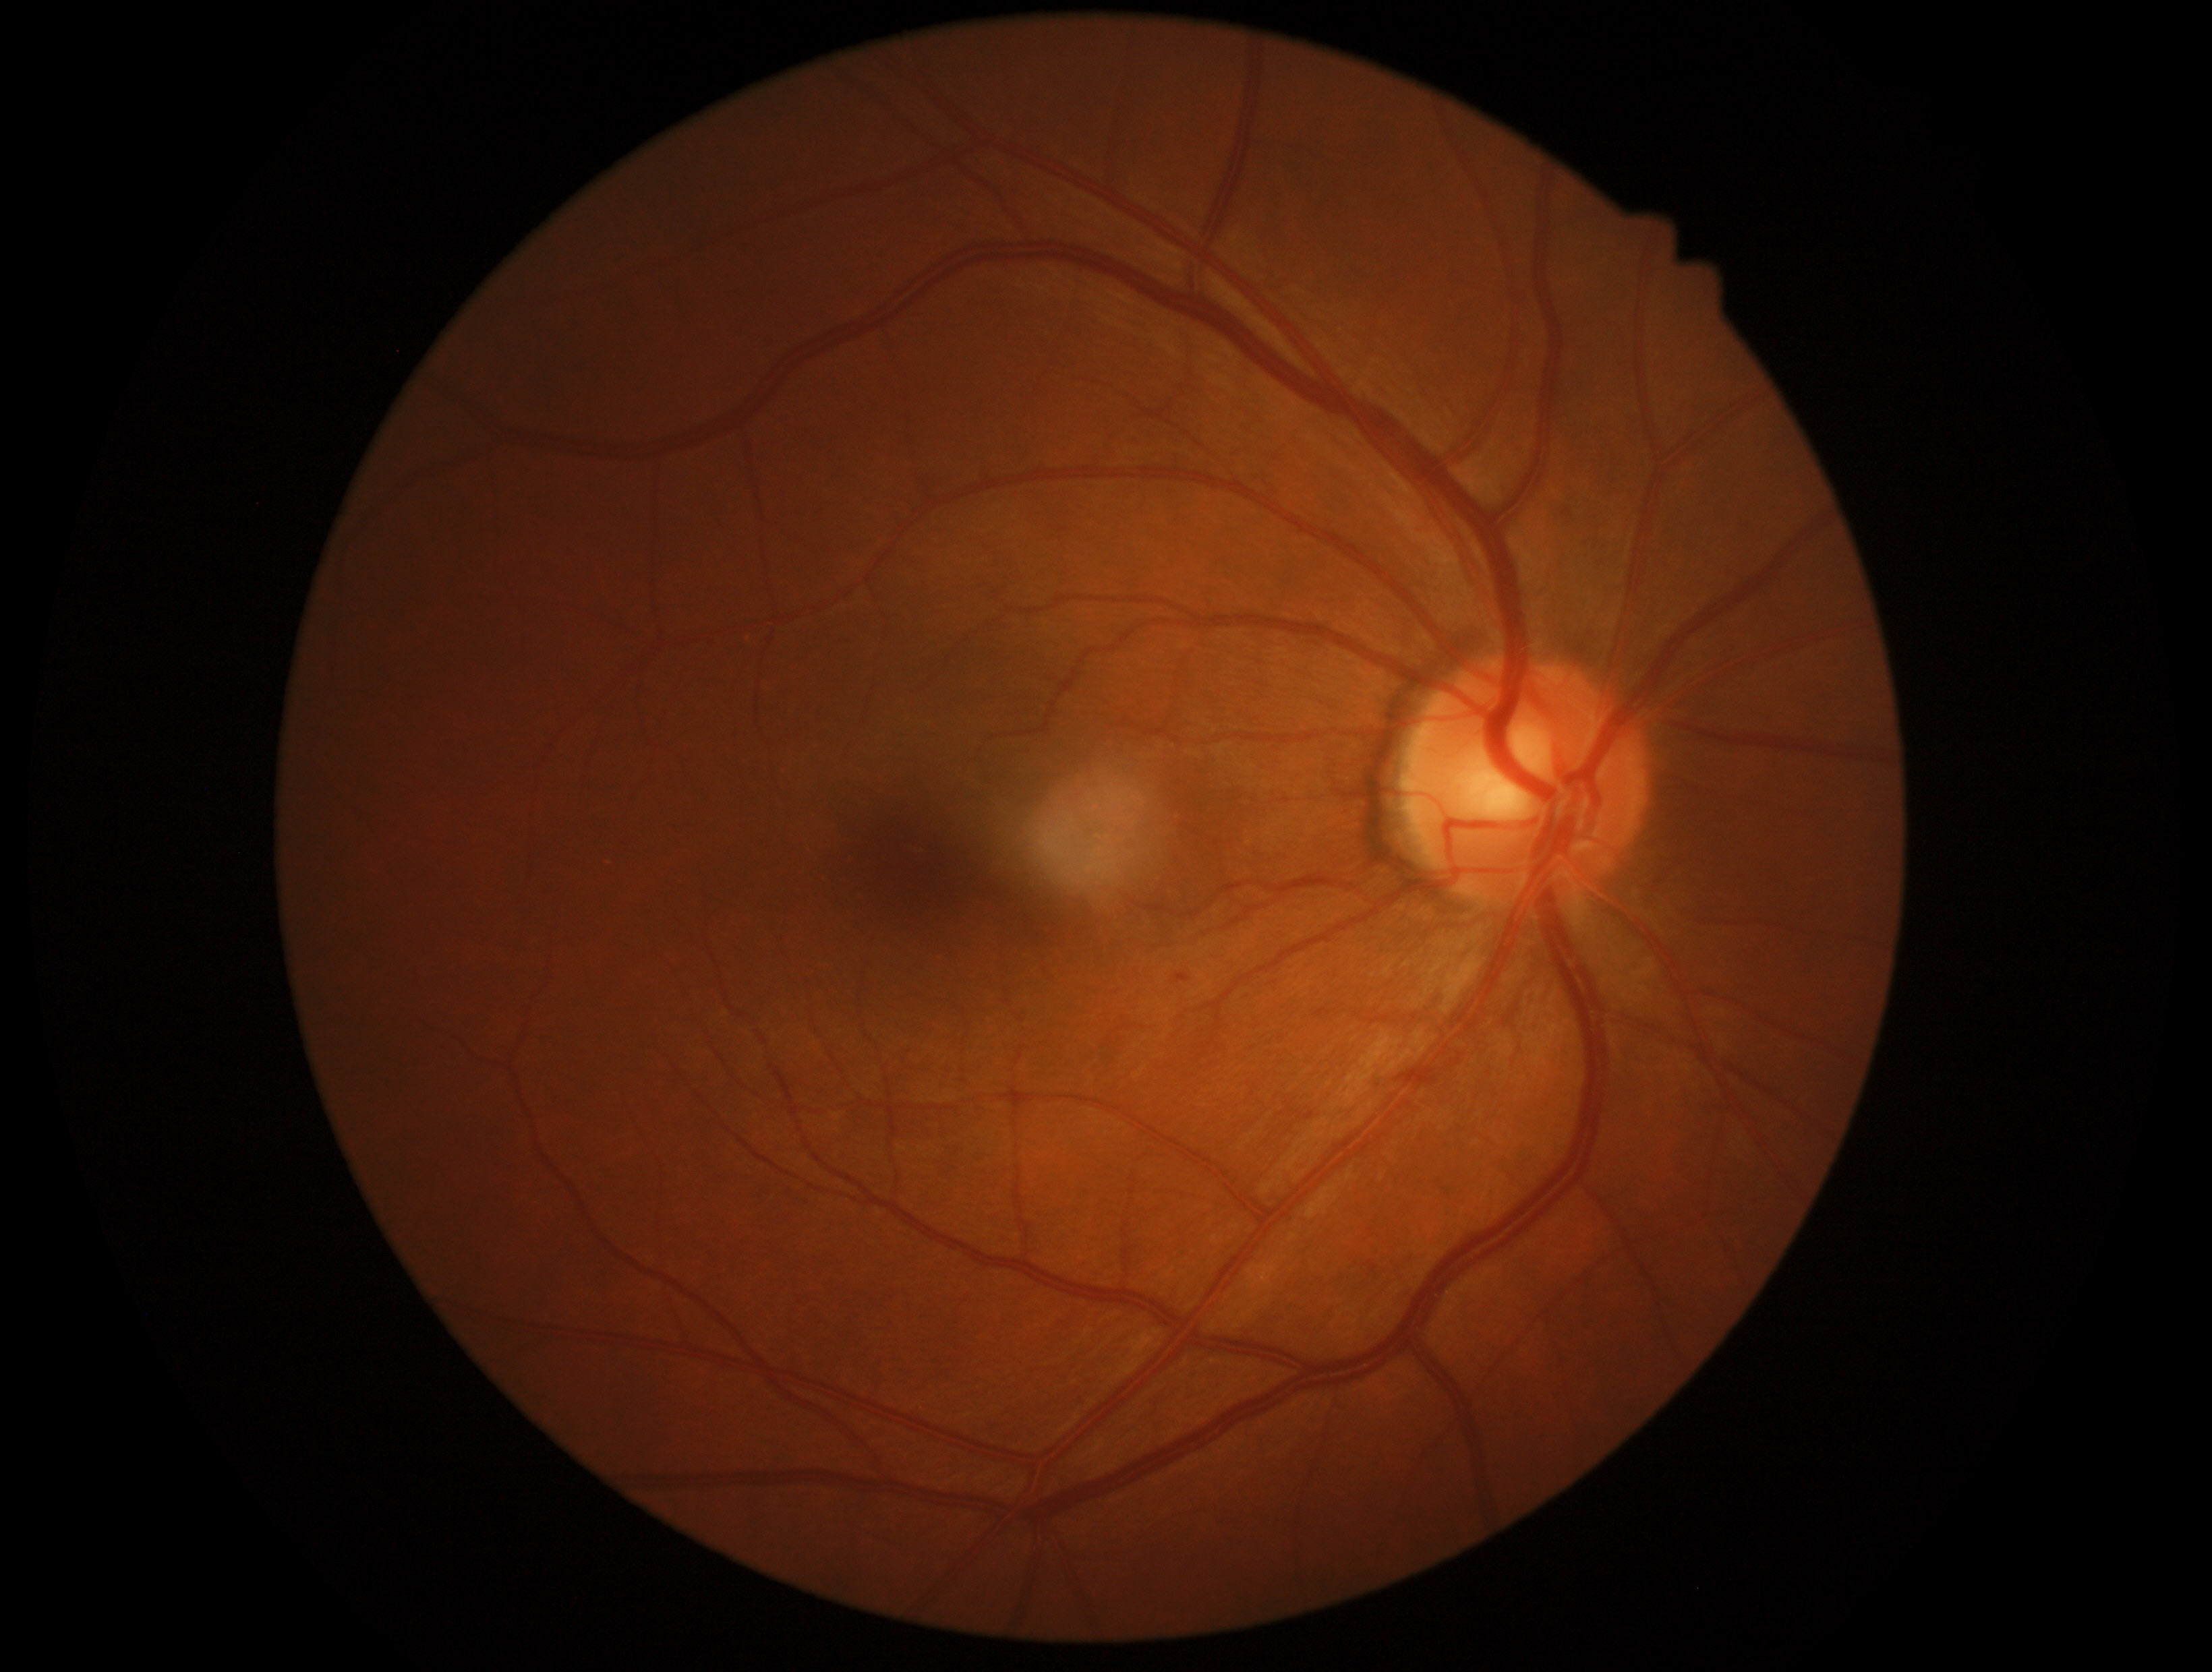 dr_grade: 1/4